RetCam wide-field infant fundus image · 640 by 480 pixels: 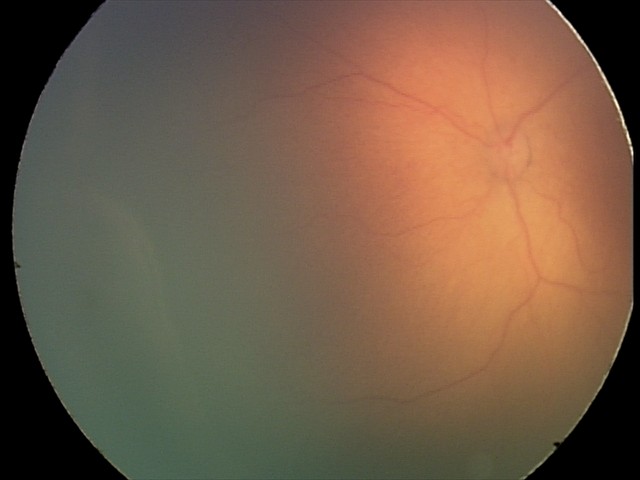

Q: What was the screening finding?
A: retinopathy of prematurity (ROP) stage 2
Q: What is the plus-form classification?
A: no plus disease